50° FOV. 2228 by 1652 pixels:
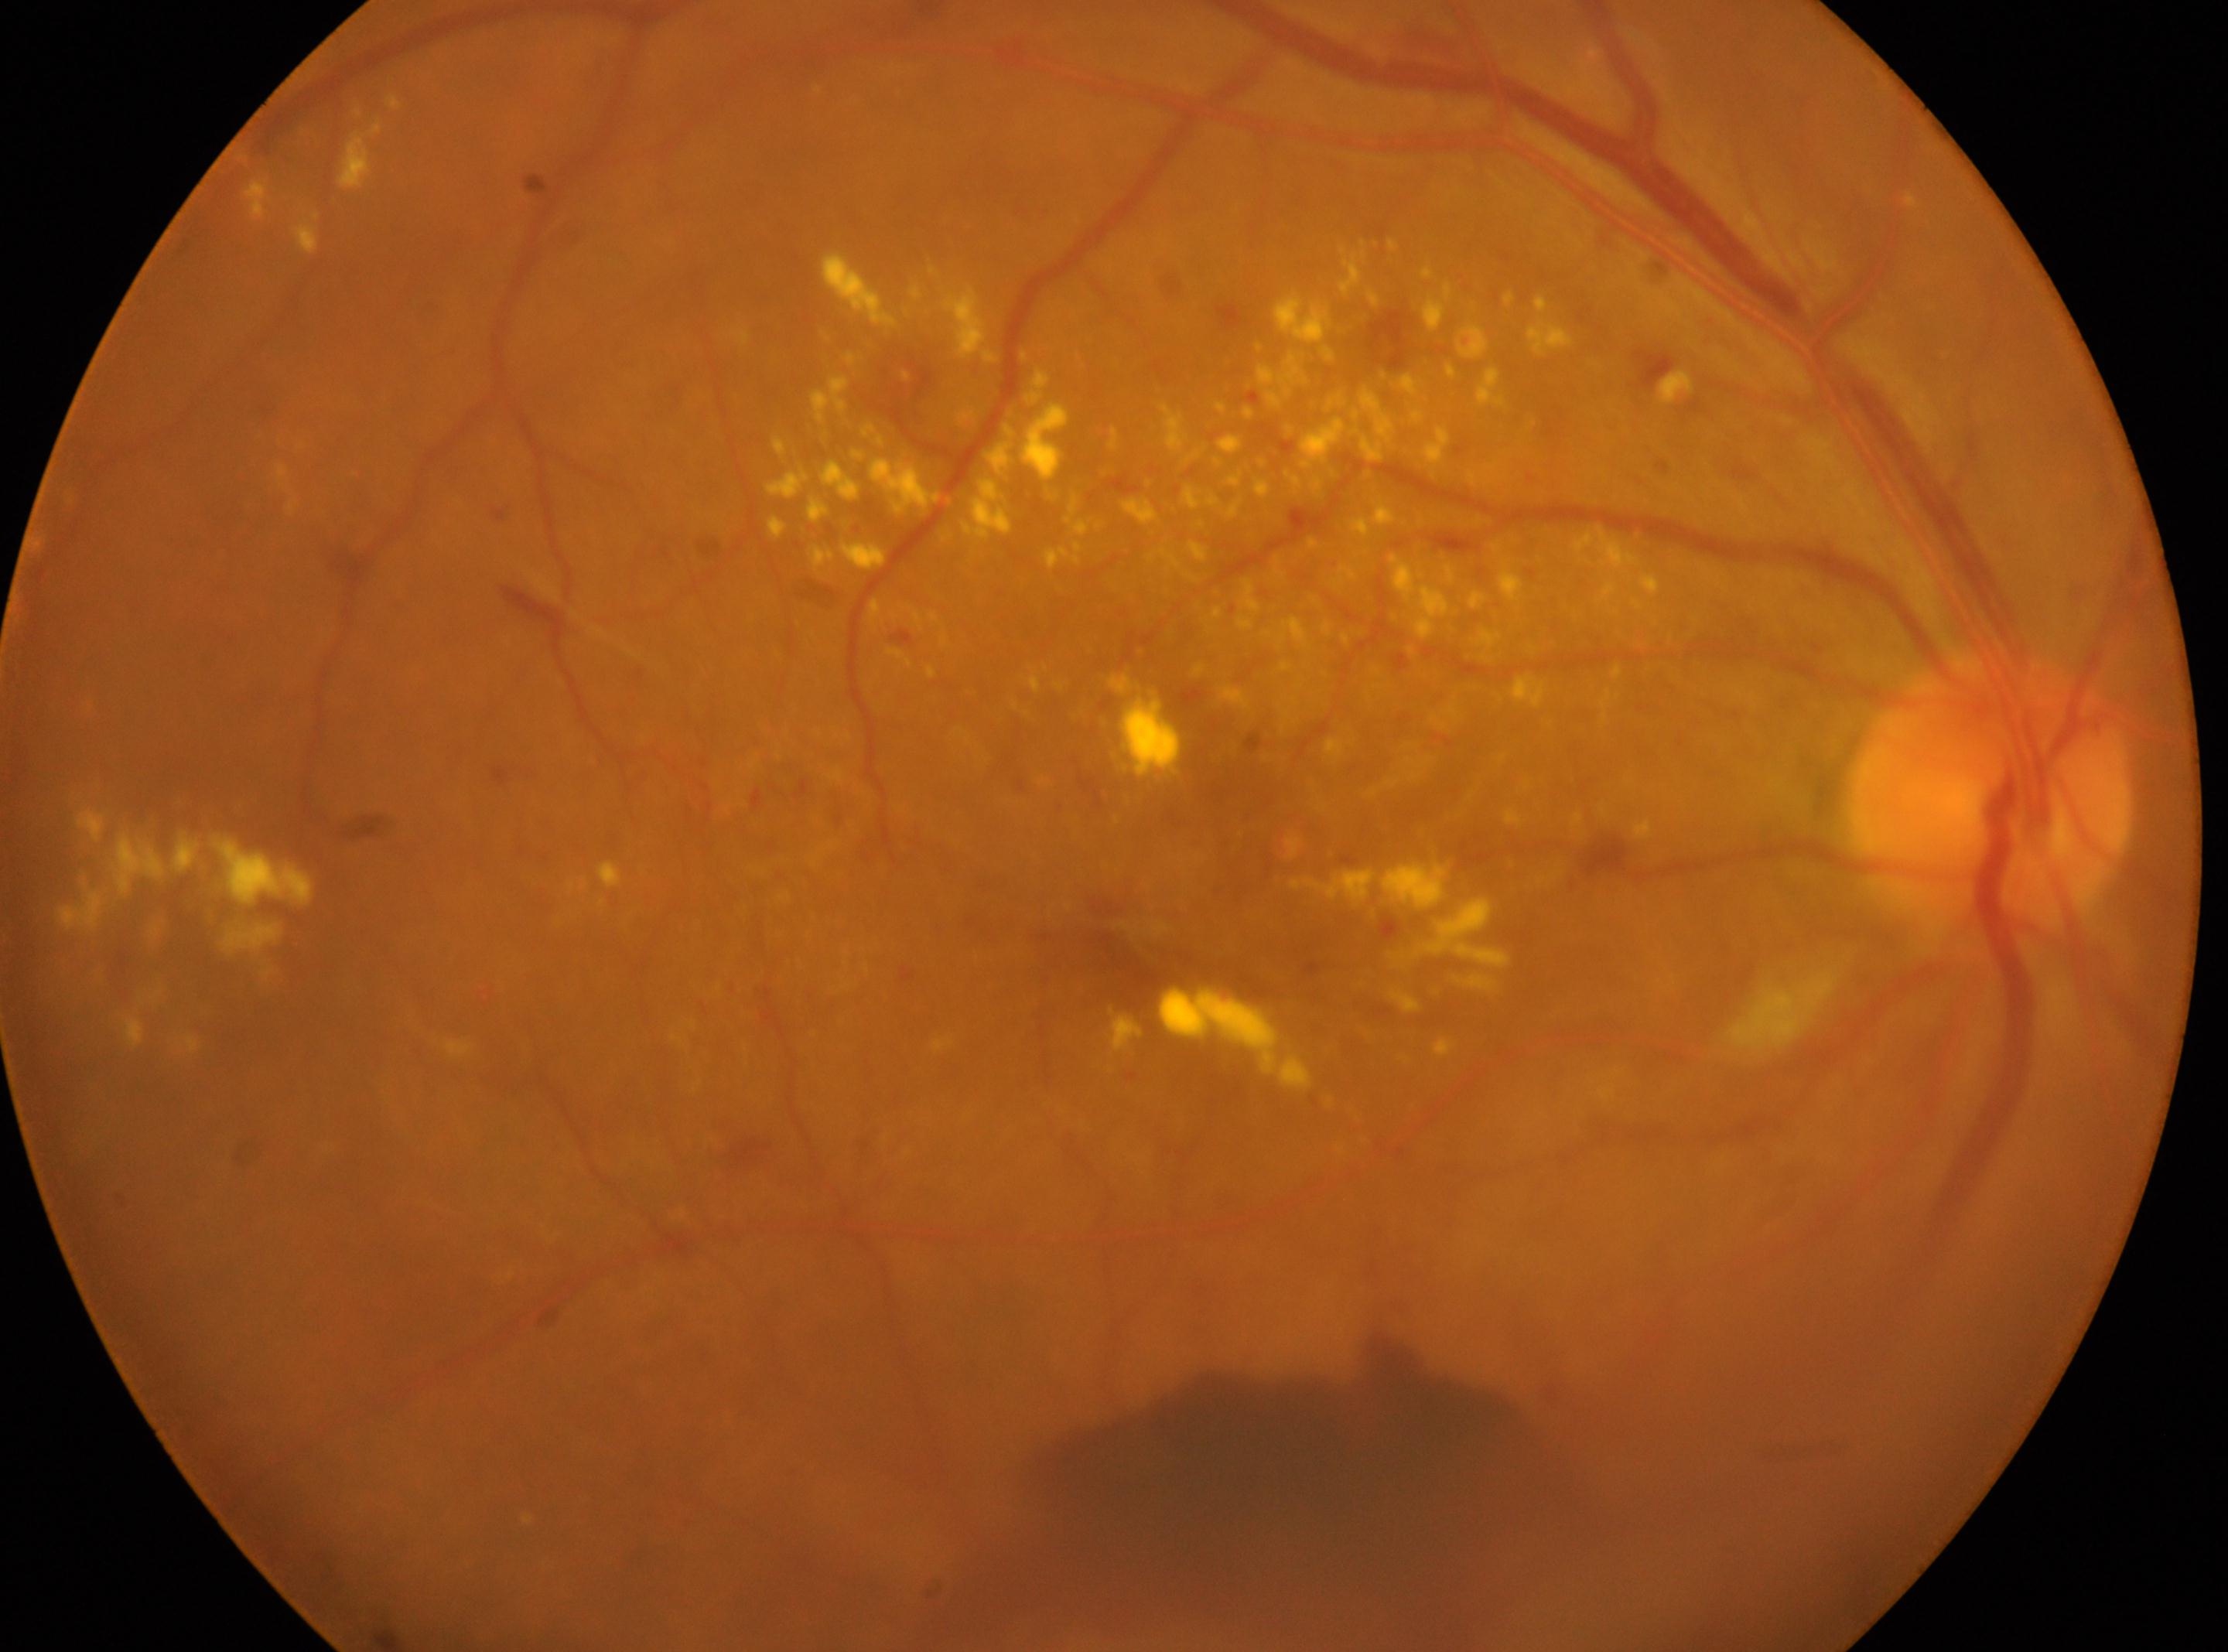
Annotations:
– fovea: 1119px, 940px
– laterality: oculus dexter
– retinopathy grade: proliferative diabetic retinopathy (4)
– optic disk: 1990px, 801px
– DR class: proliferative diabetic retinopathy